Posterior pole color fundus photograph · modified Davis grading — 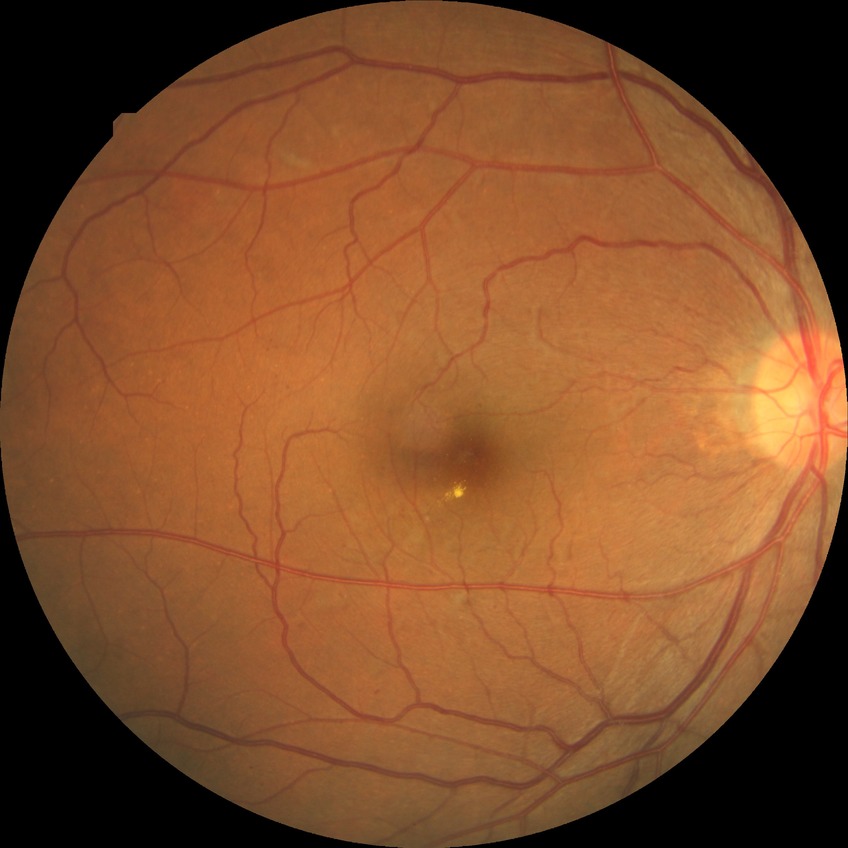

- diabetic retinopathy (DR) — SDR (simple diabetic retinopathy)